Color fundus image:
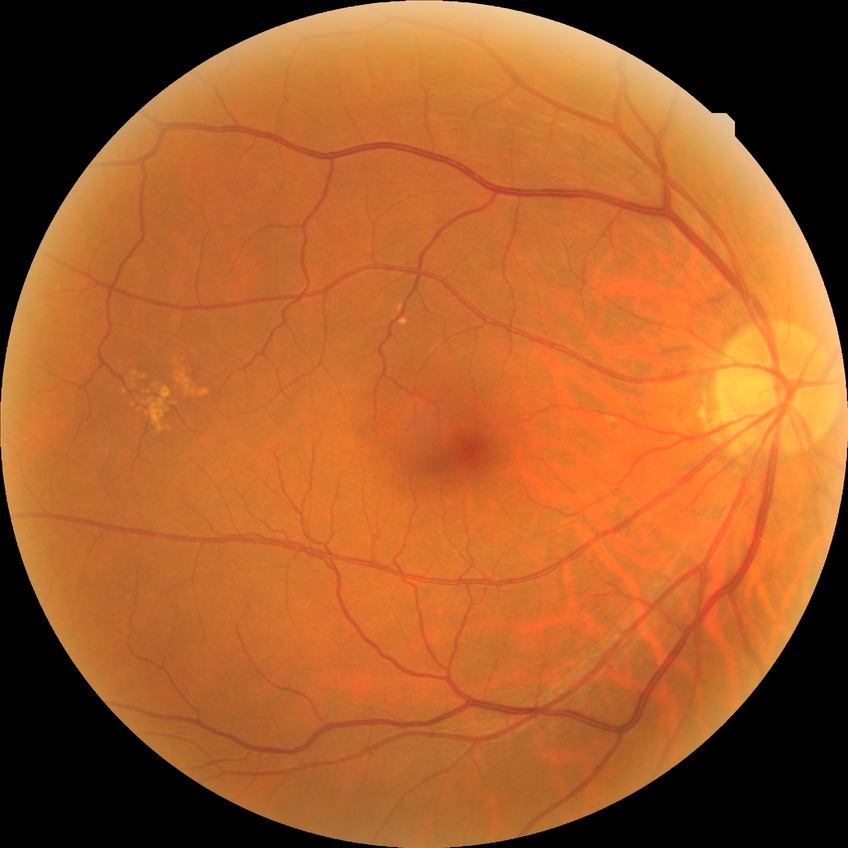 Retinopathy stage is no diabetic retinopathy.